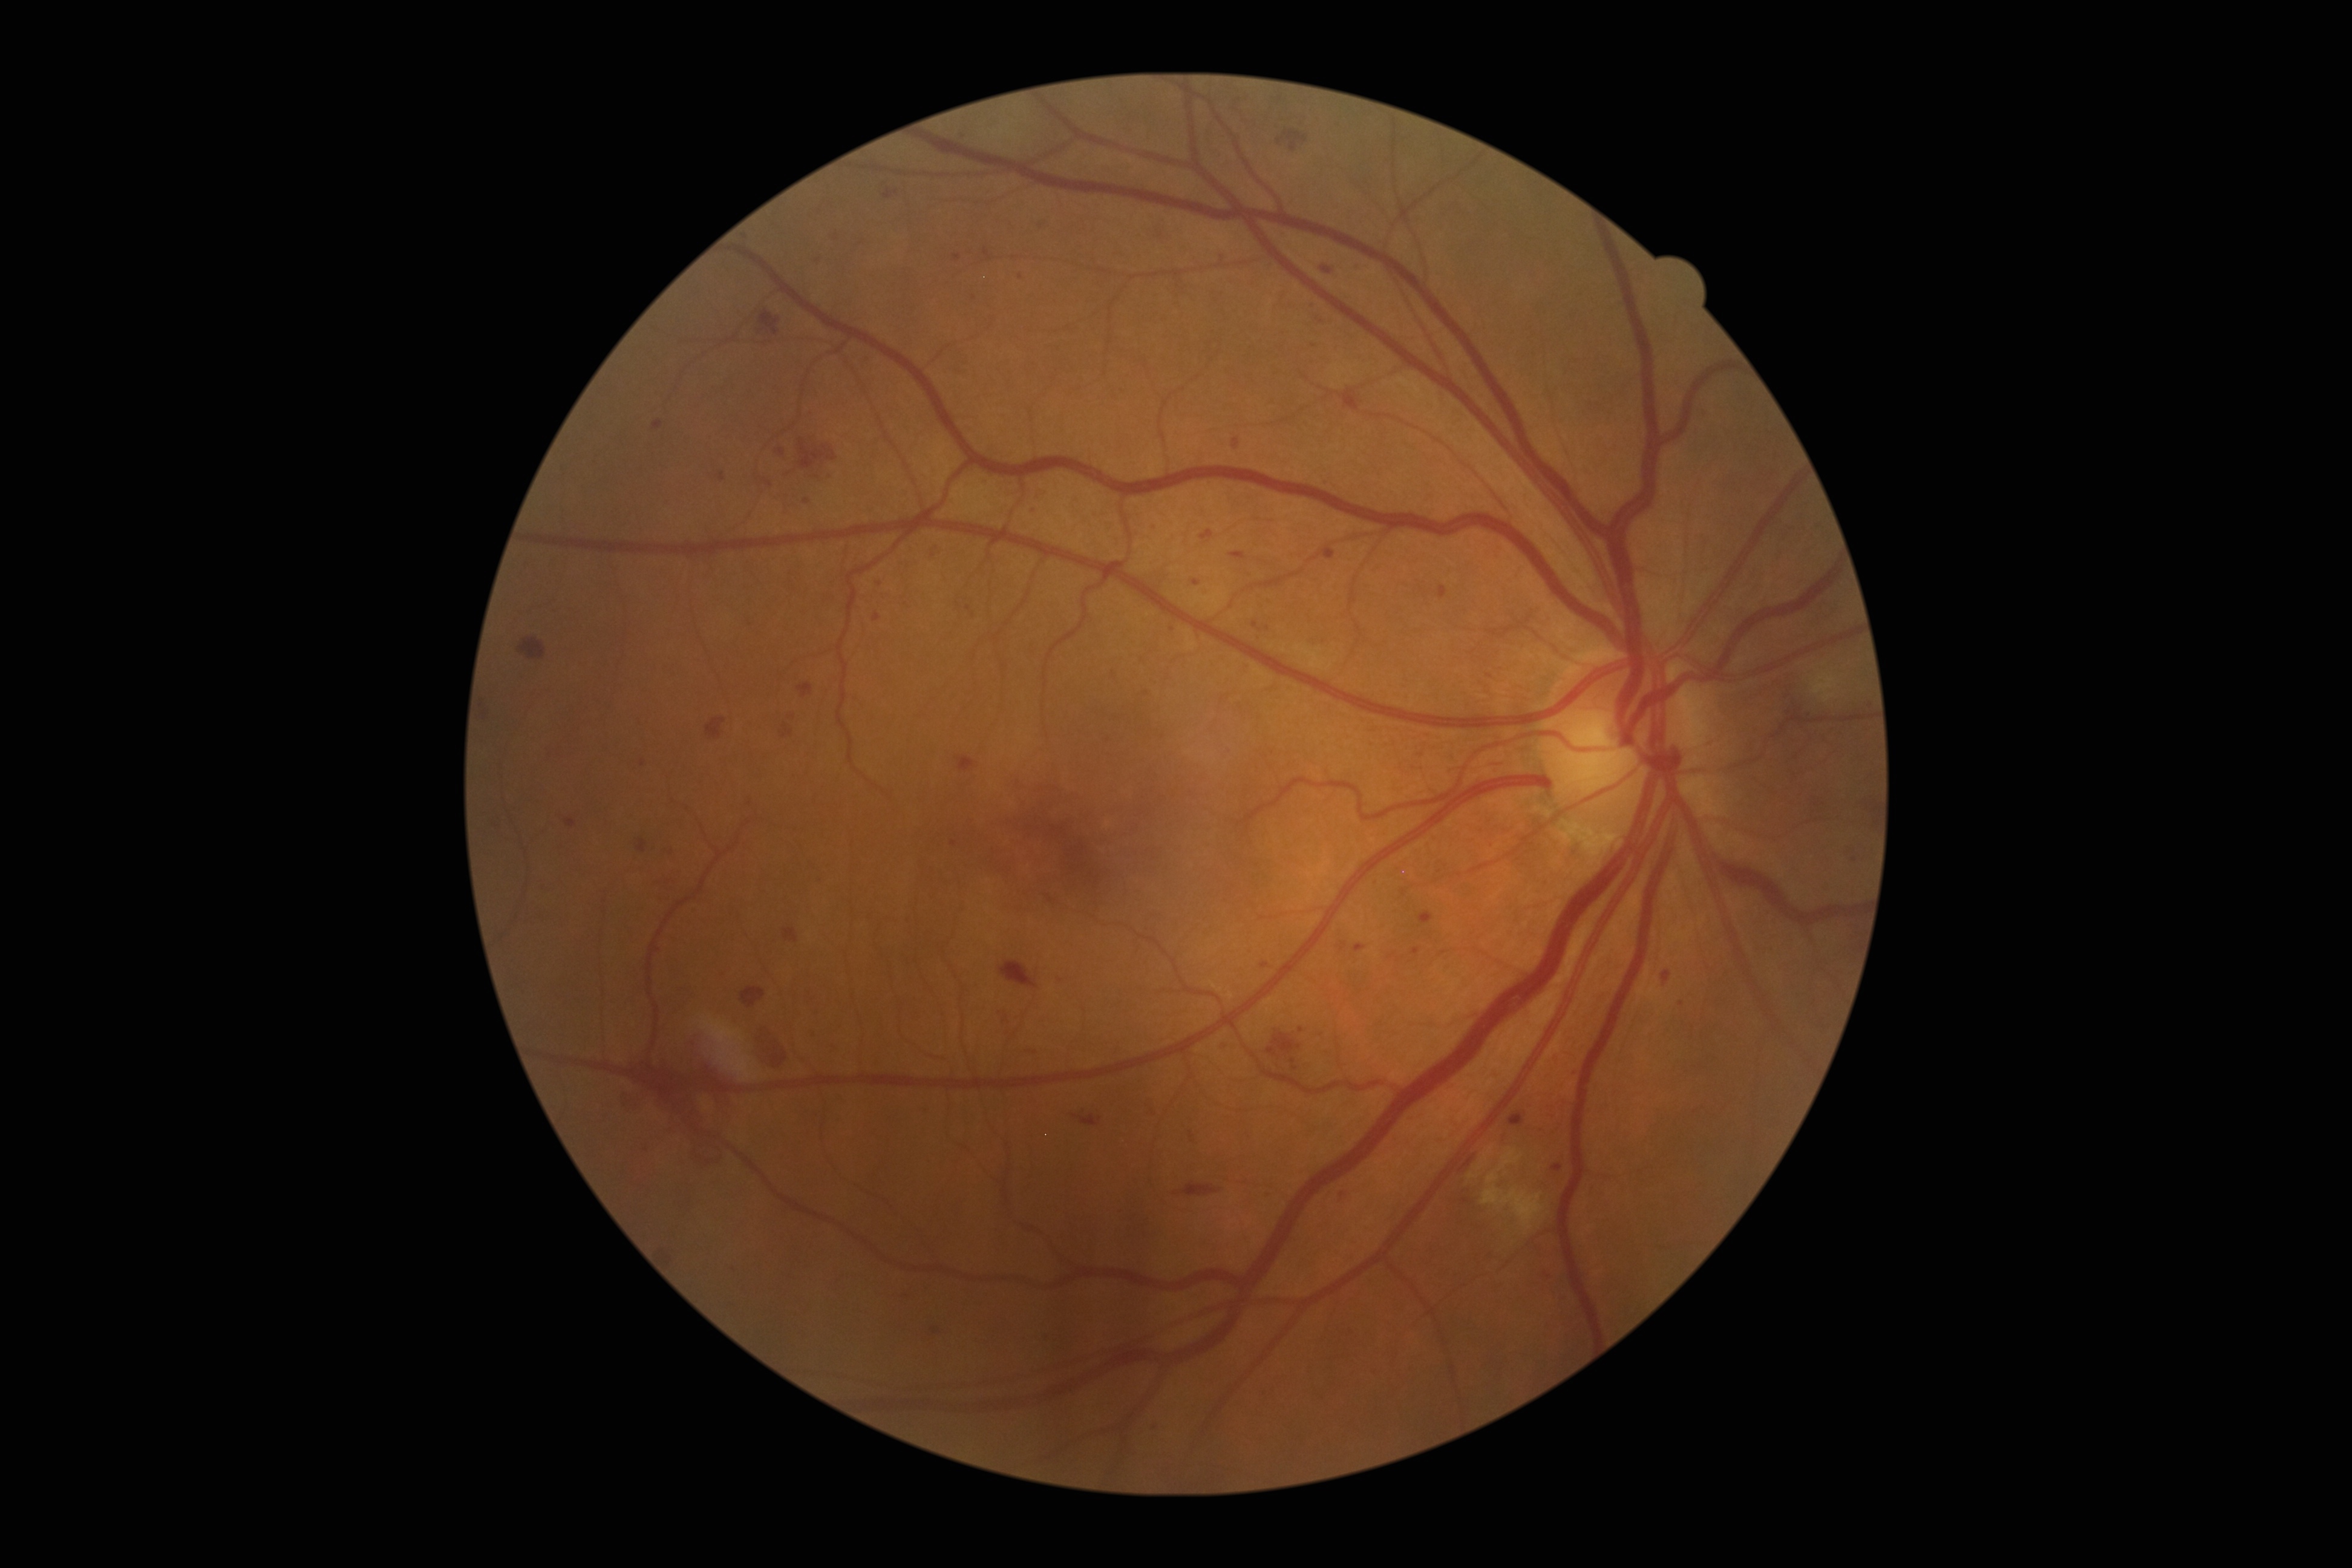

<lesions partial="true">
  <dr_grade>3</dr_grade>
  <ma partial="true">817:260:825:267 | 1233:437:1240:449 | 1230:552:1246:561 | 923:1104:933:1112 | 1354:944:1367:953 | 1322:546:1336:561 | 1266:1194:1272:1202 | 1192:580:1201:587 | 834:233:845:247</ma>
  <ma_small_approx>1809/713 | 1361/266 | 1192/1135 | 793/716 | 791/474 | 1293/1060 | 1147/693 | 1465/1200</ma_small_approx>
</lesions>